Color fundus image:
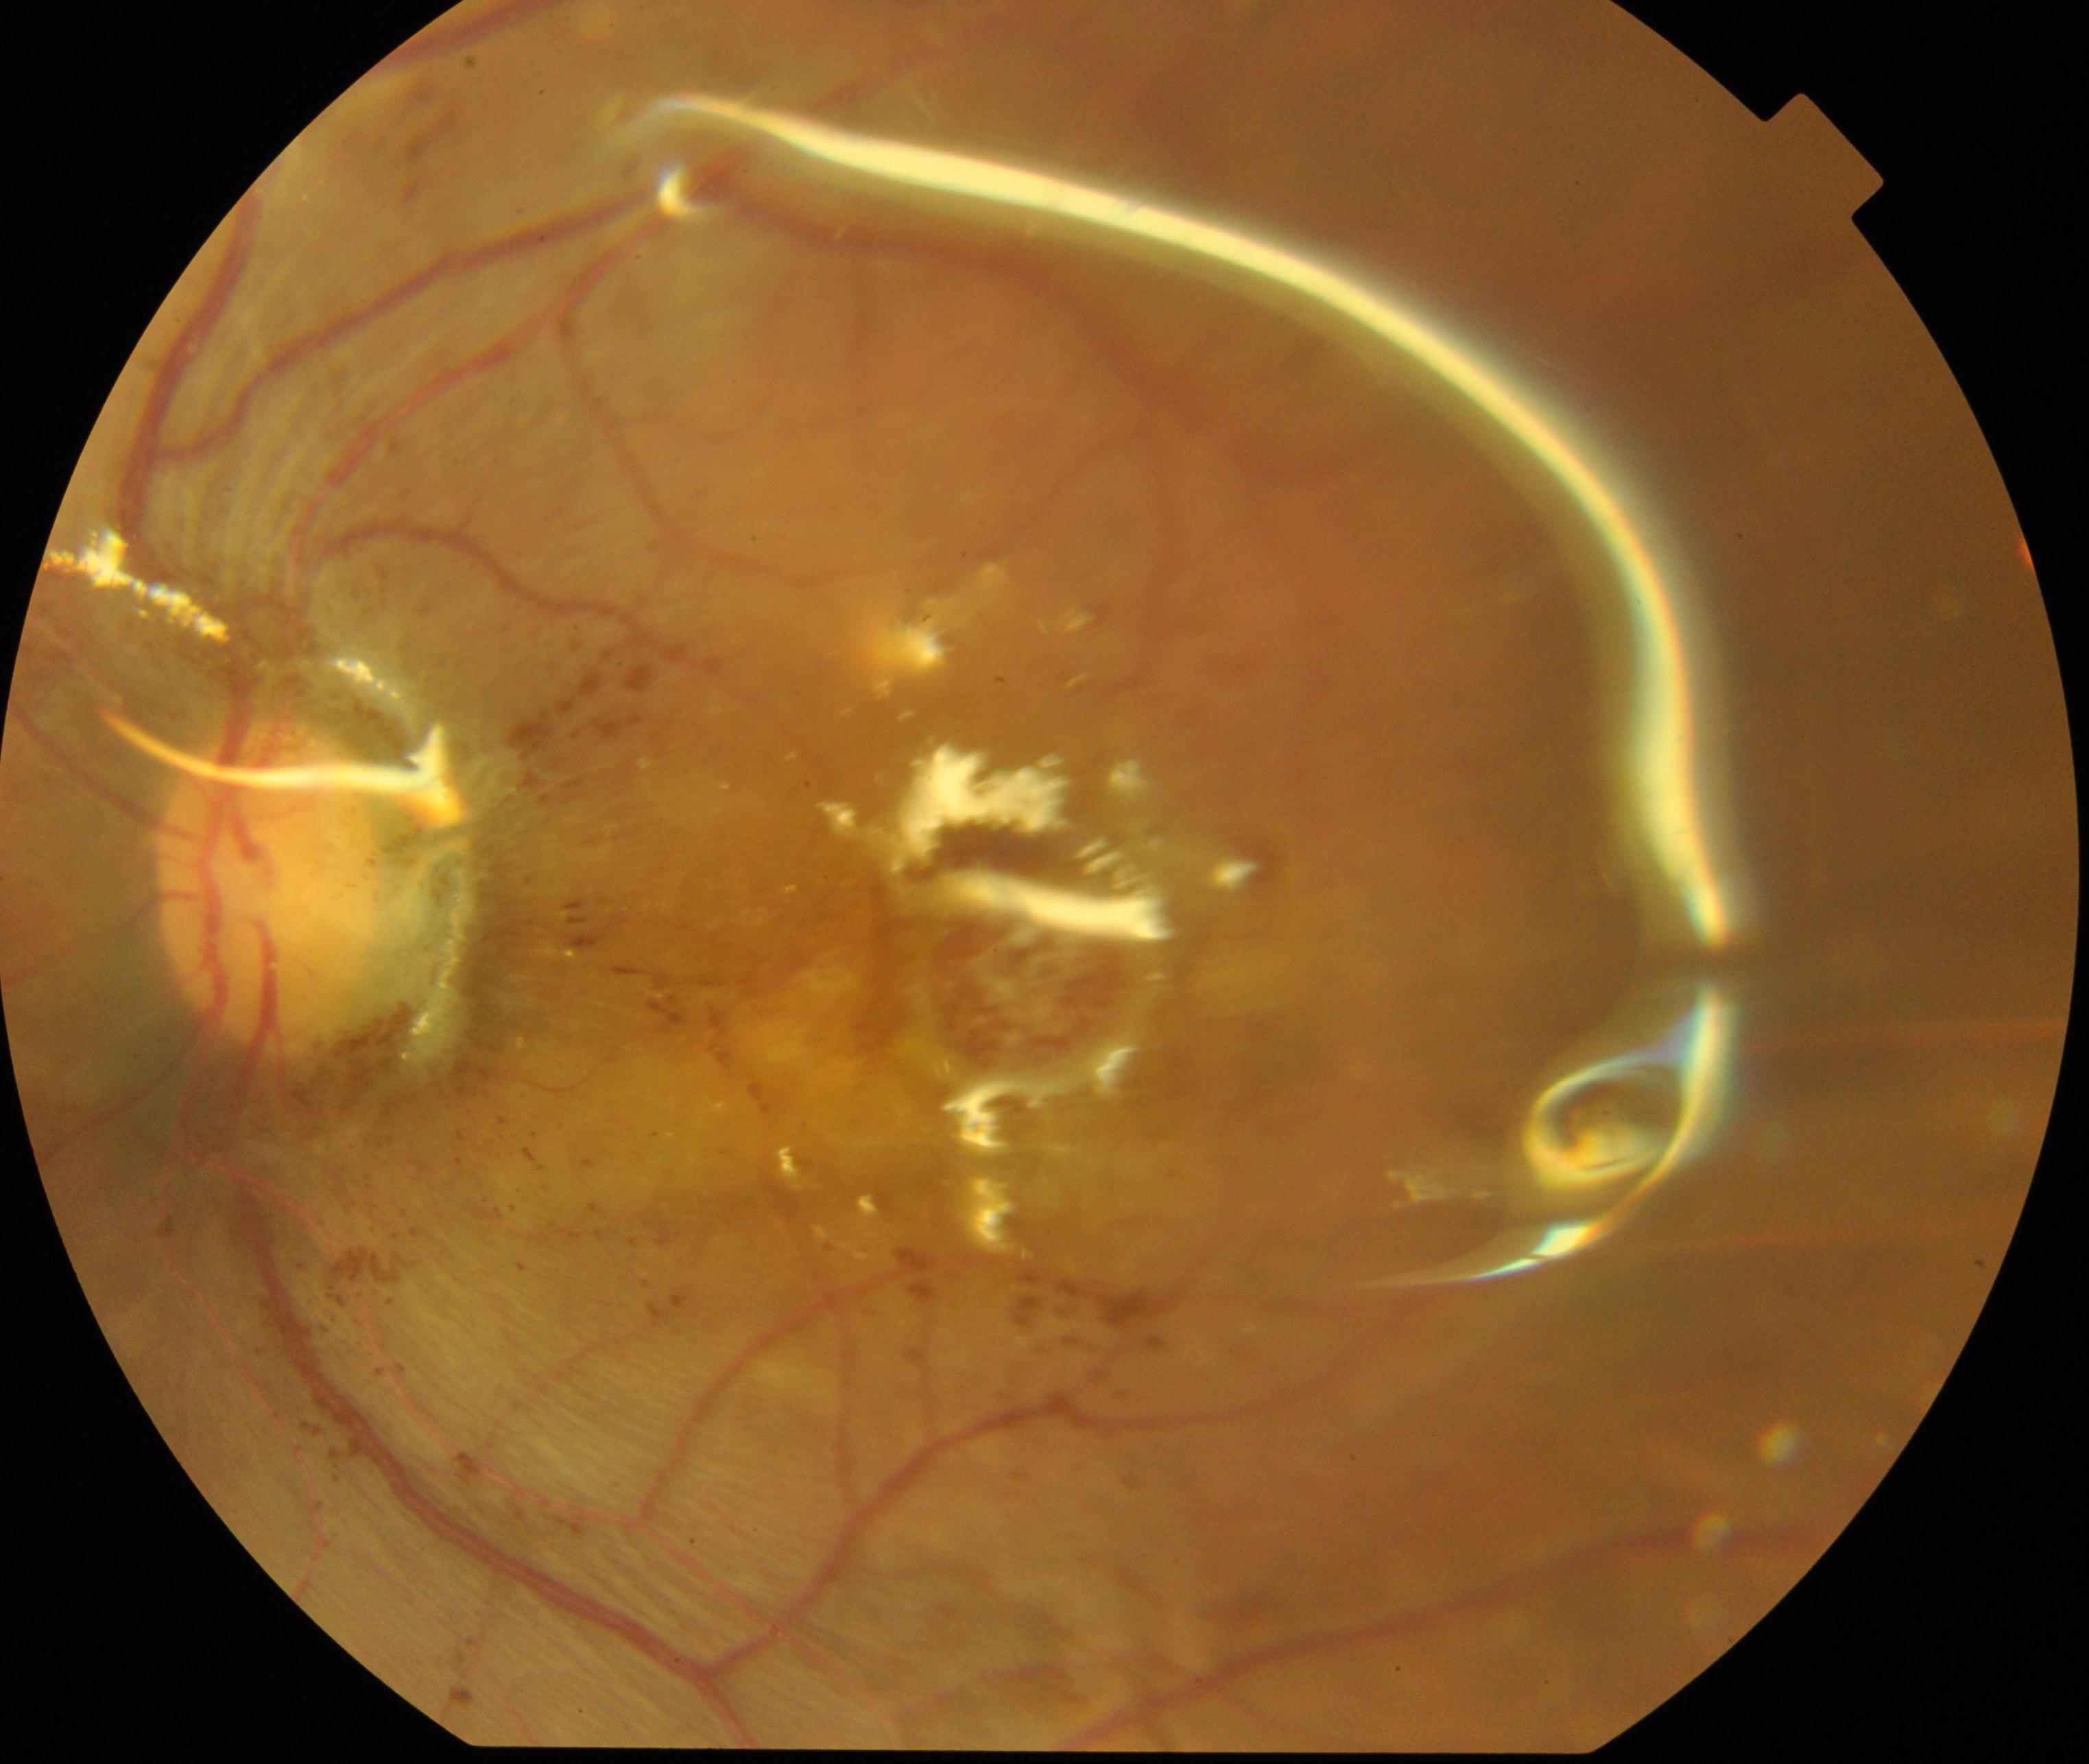

Silicone oil in the eye visible.